640 x 480 pixels; Clarity RetCam 3, 130° FOV; RetCam wide-field infant fundus image: 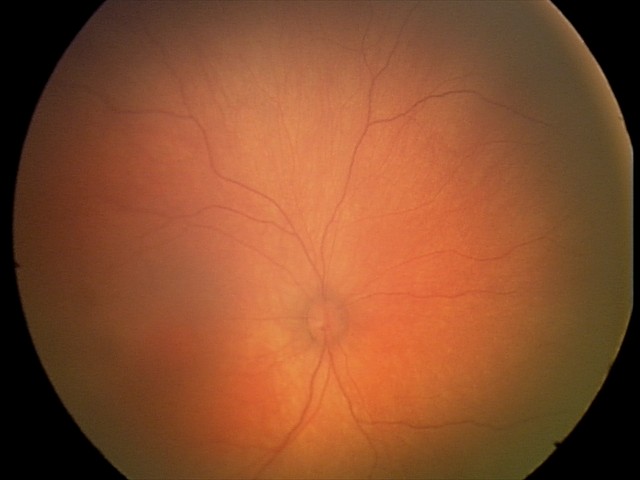
Normal screening examination.